45° field of view, CFP, 1470 by 1137 pixels — 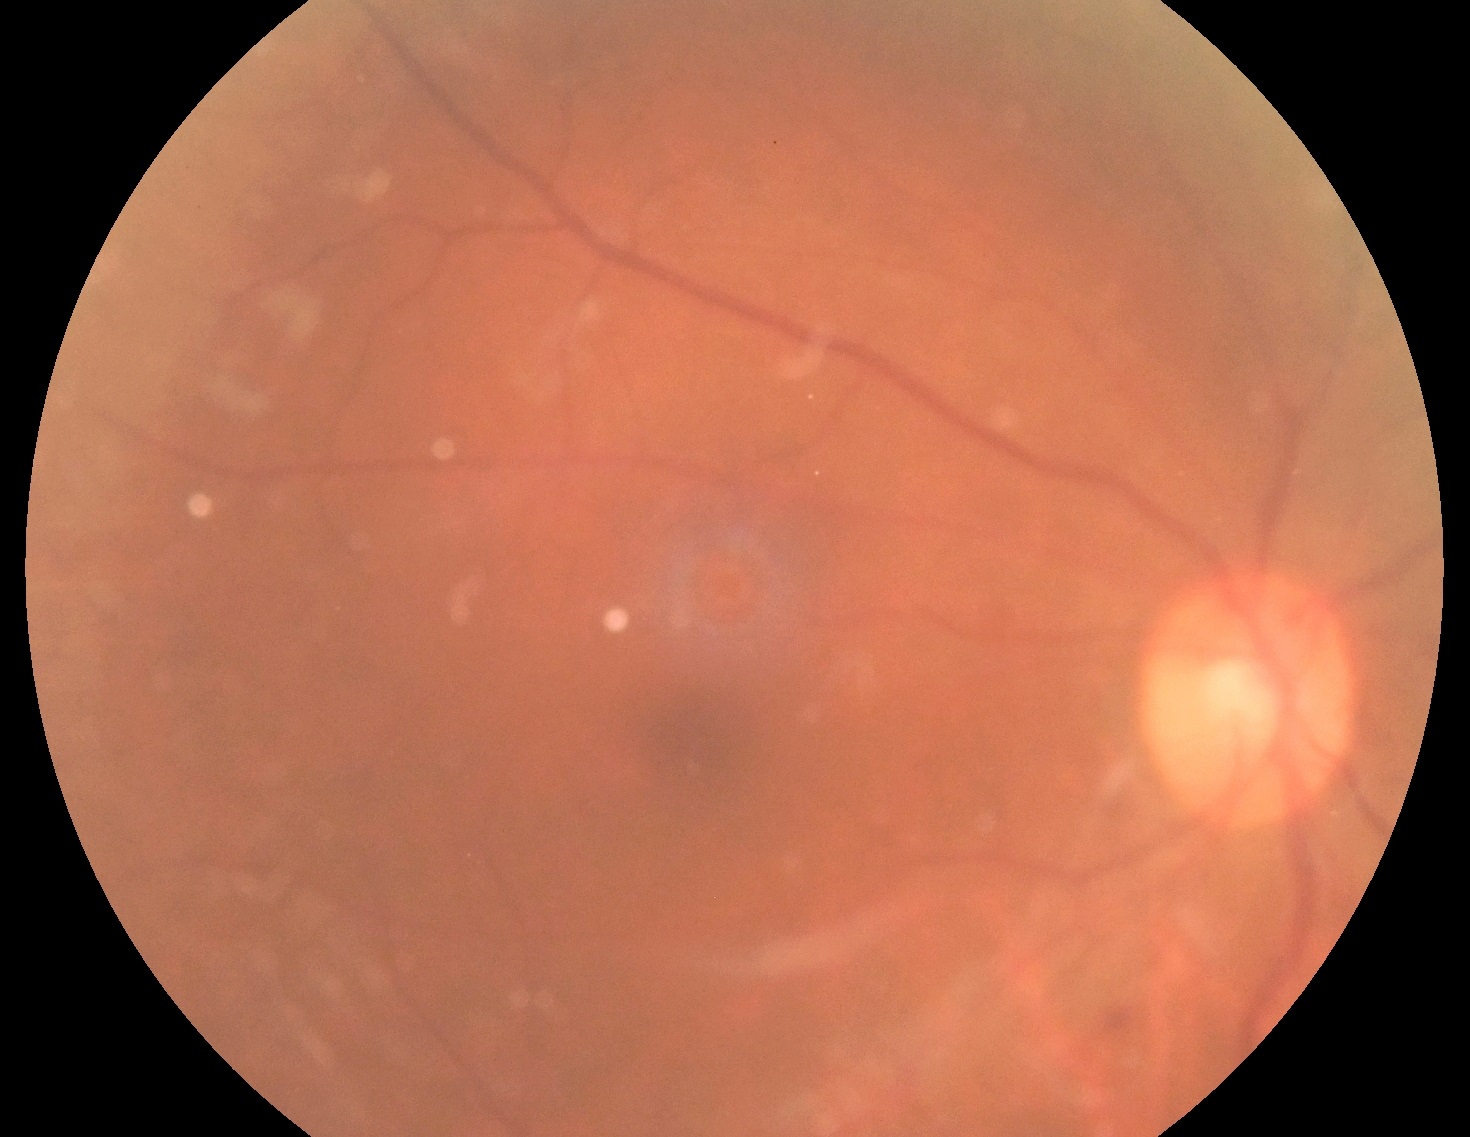
DR grade is 2 (moderate NPDR).